45° FOV:
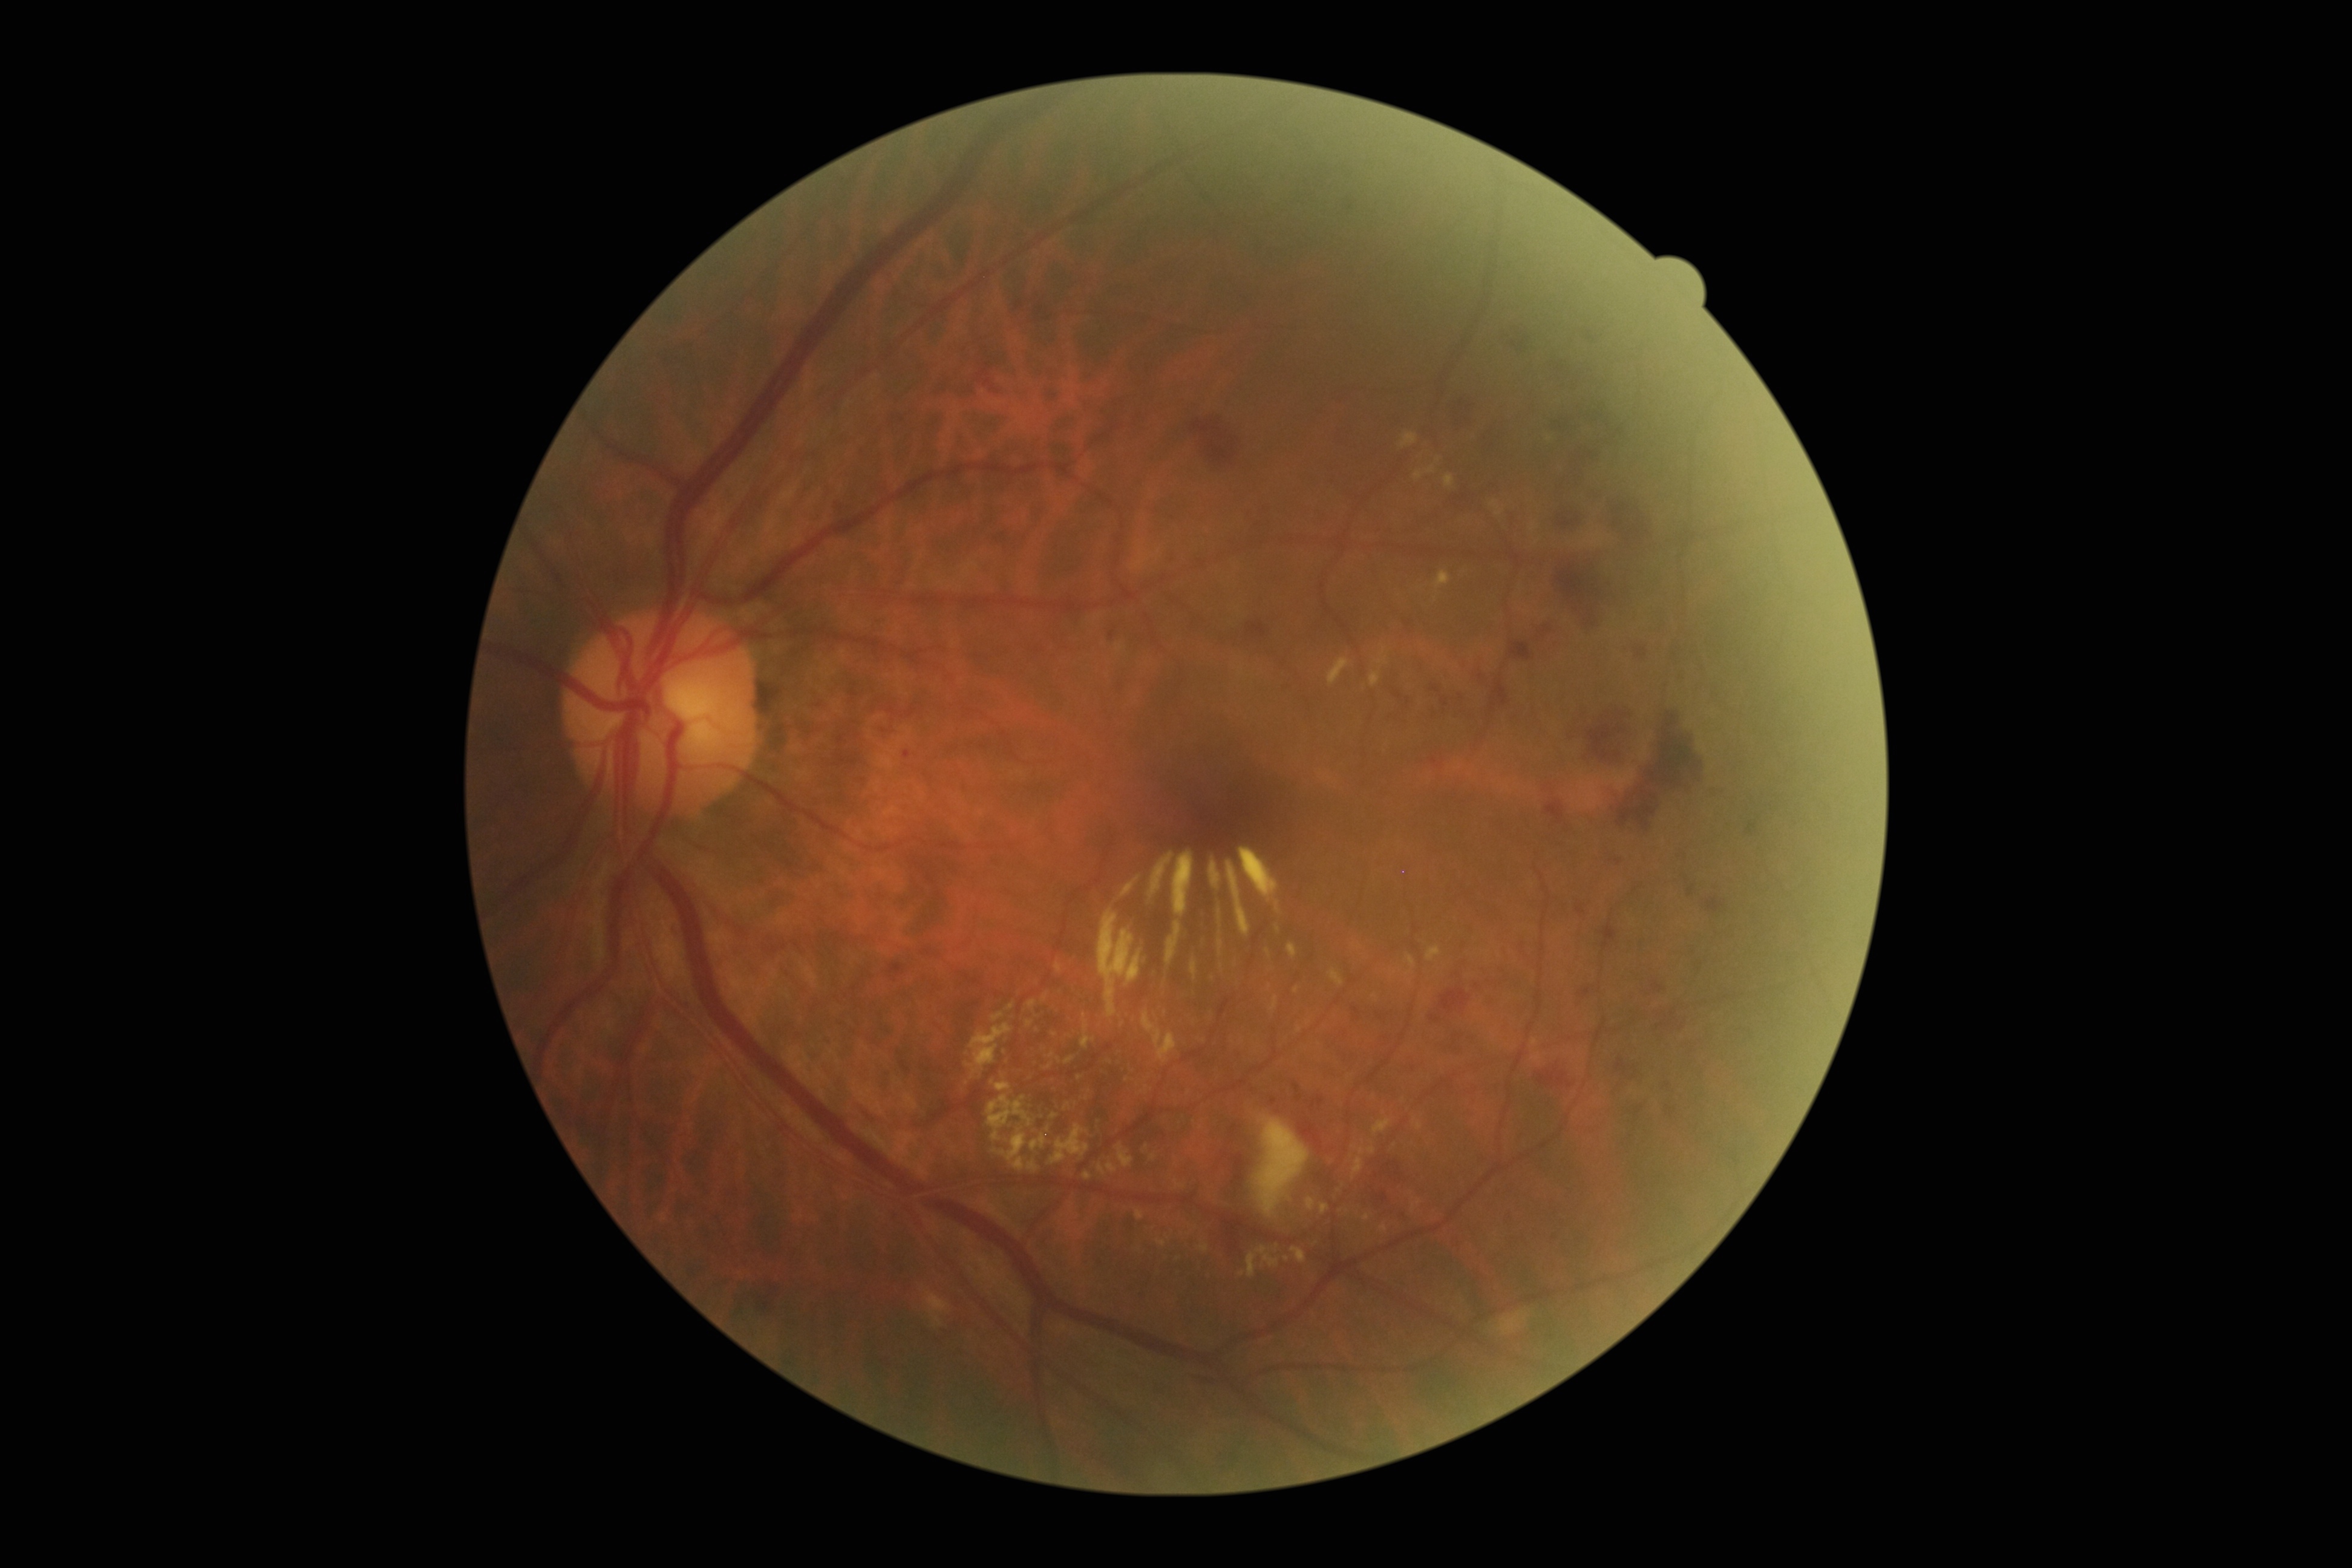 DR severity is grade 3. The retinopathy is classified as non-proliferative diabetic retinopathy.